45-degree field of view — 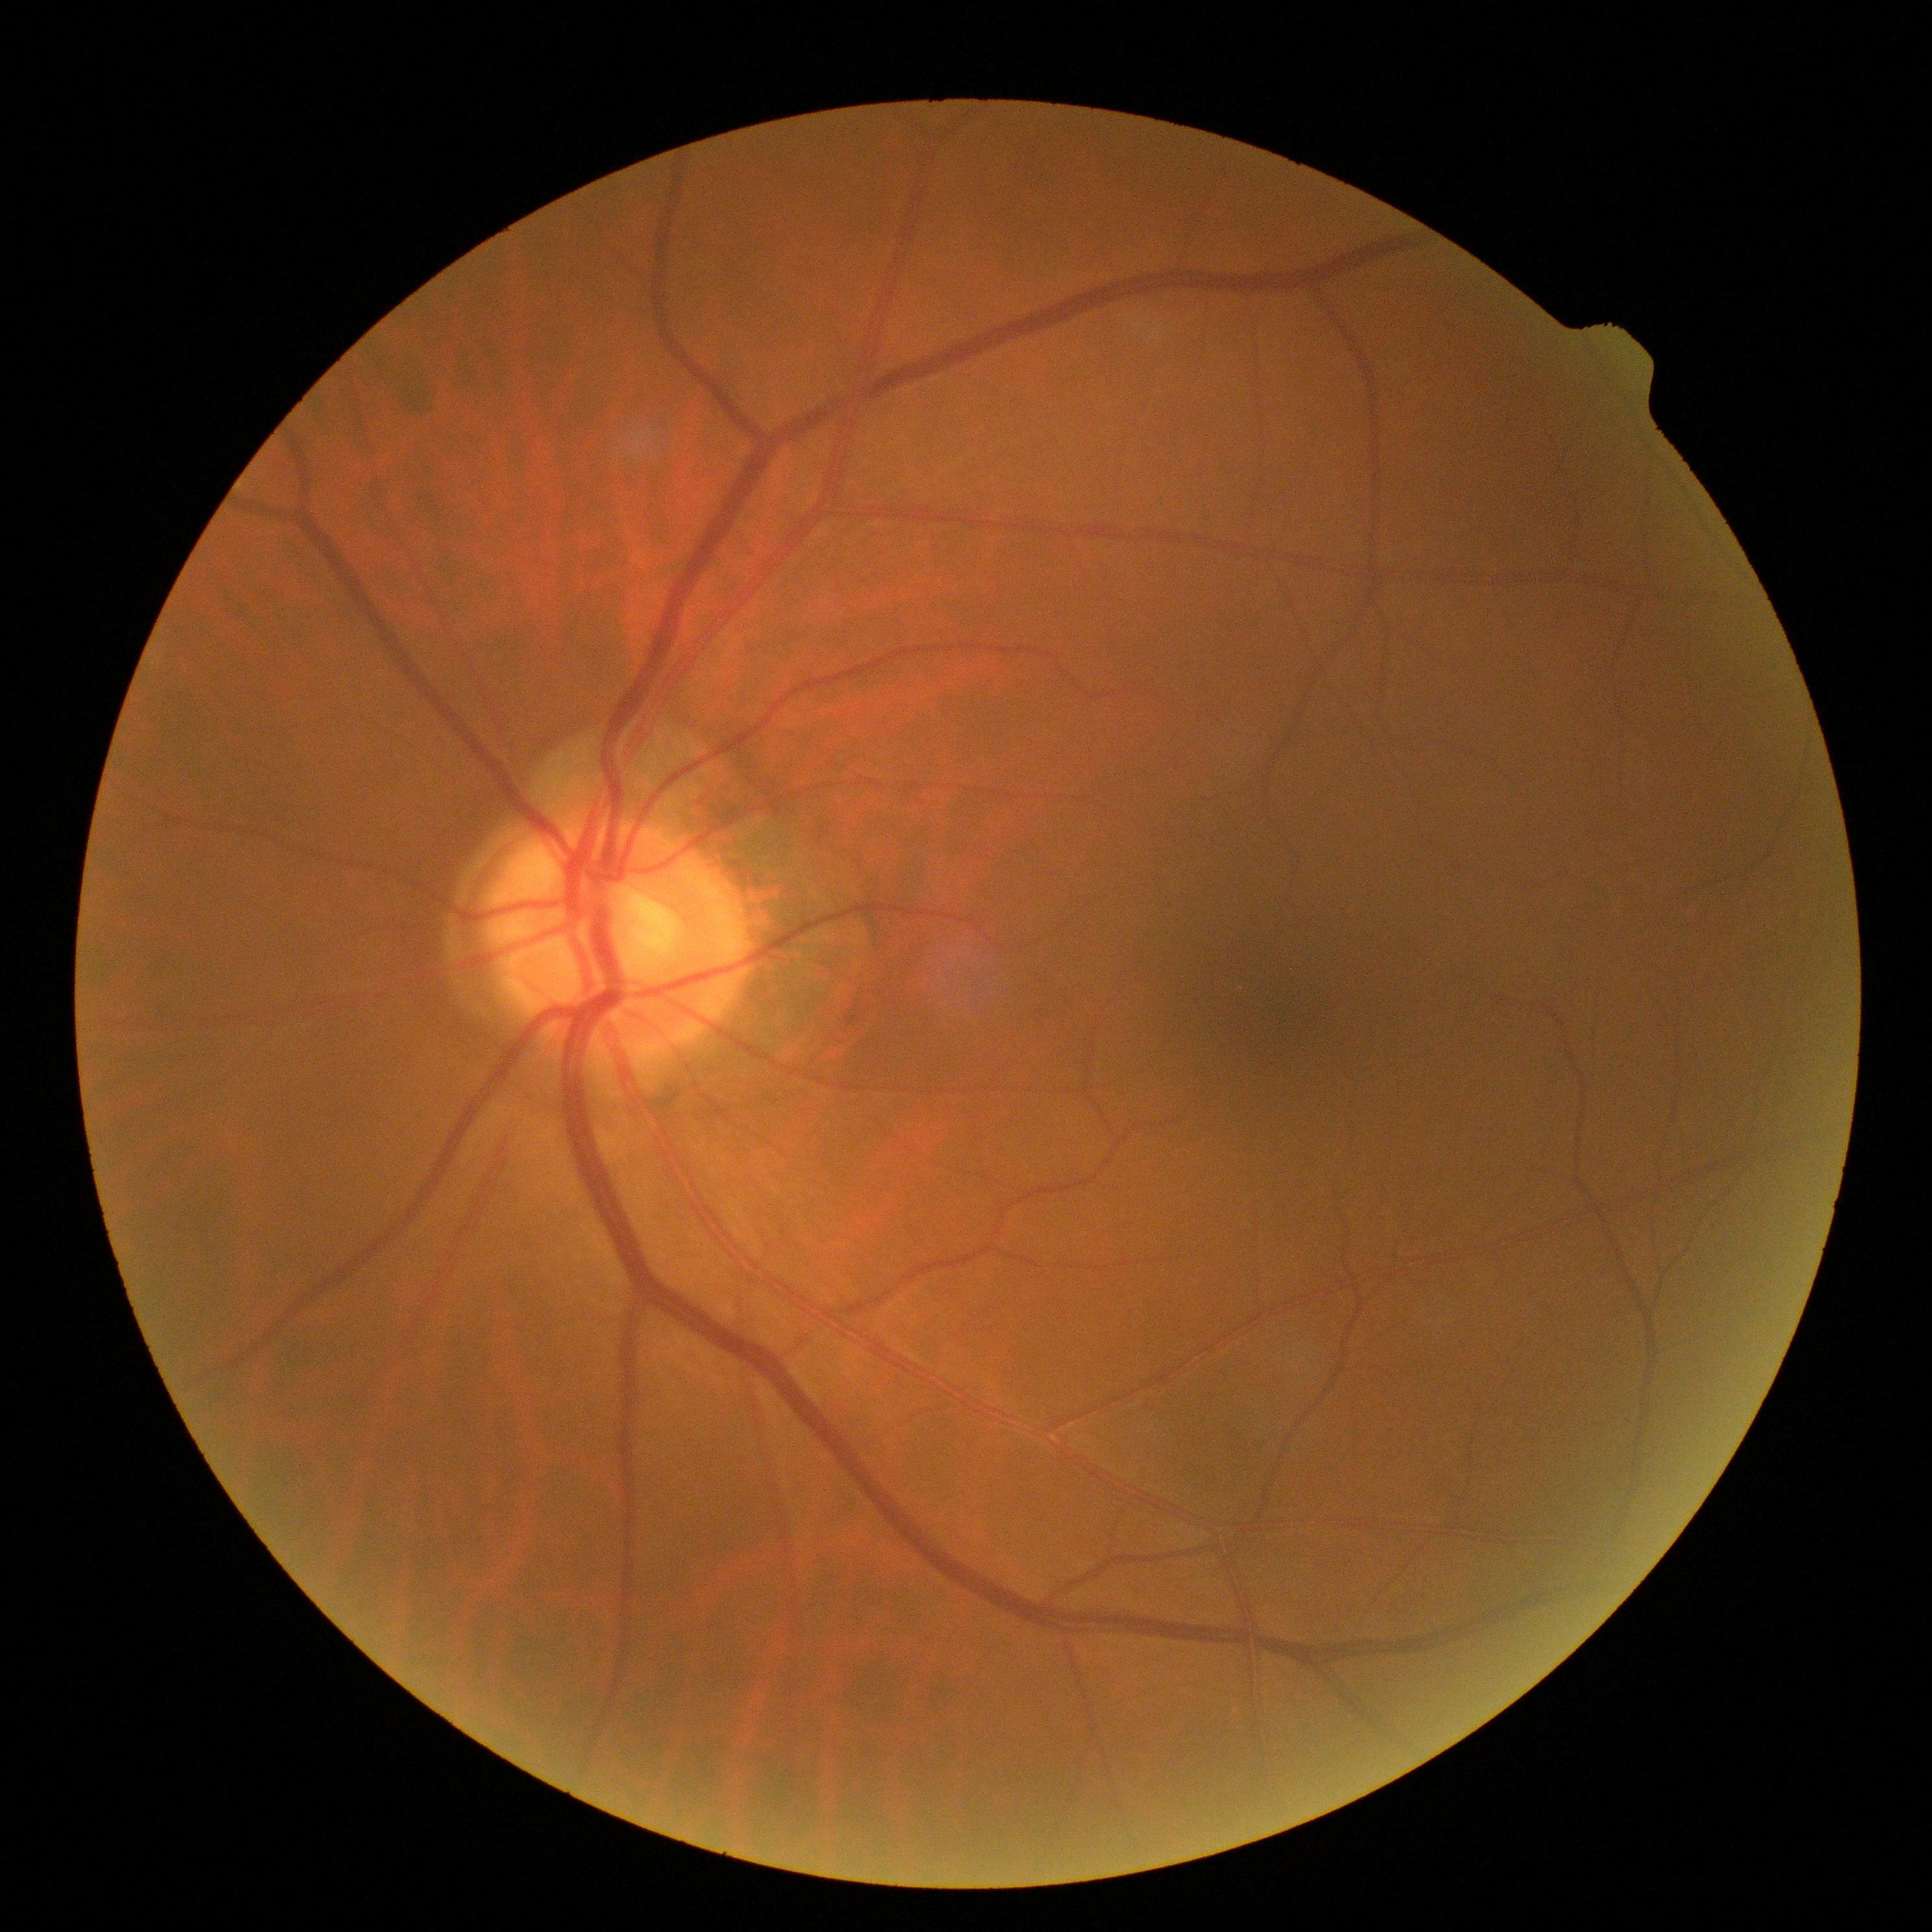 DR impression: no apparent DR; diabetic retinopathy (DR): grade 0 — no visible signs of diabetic retinopathy.